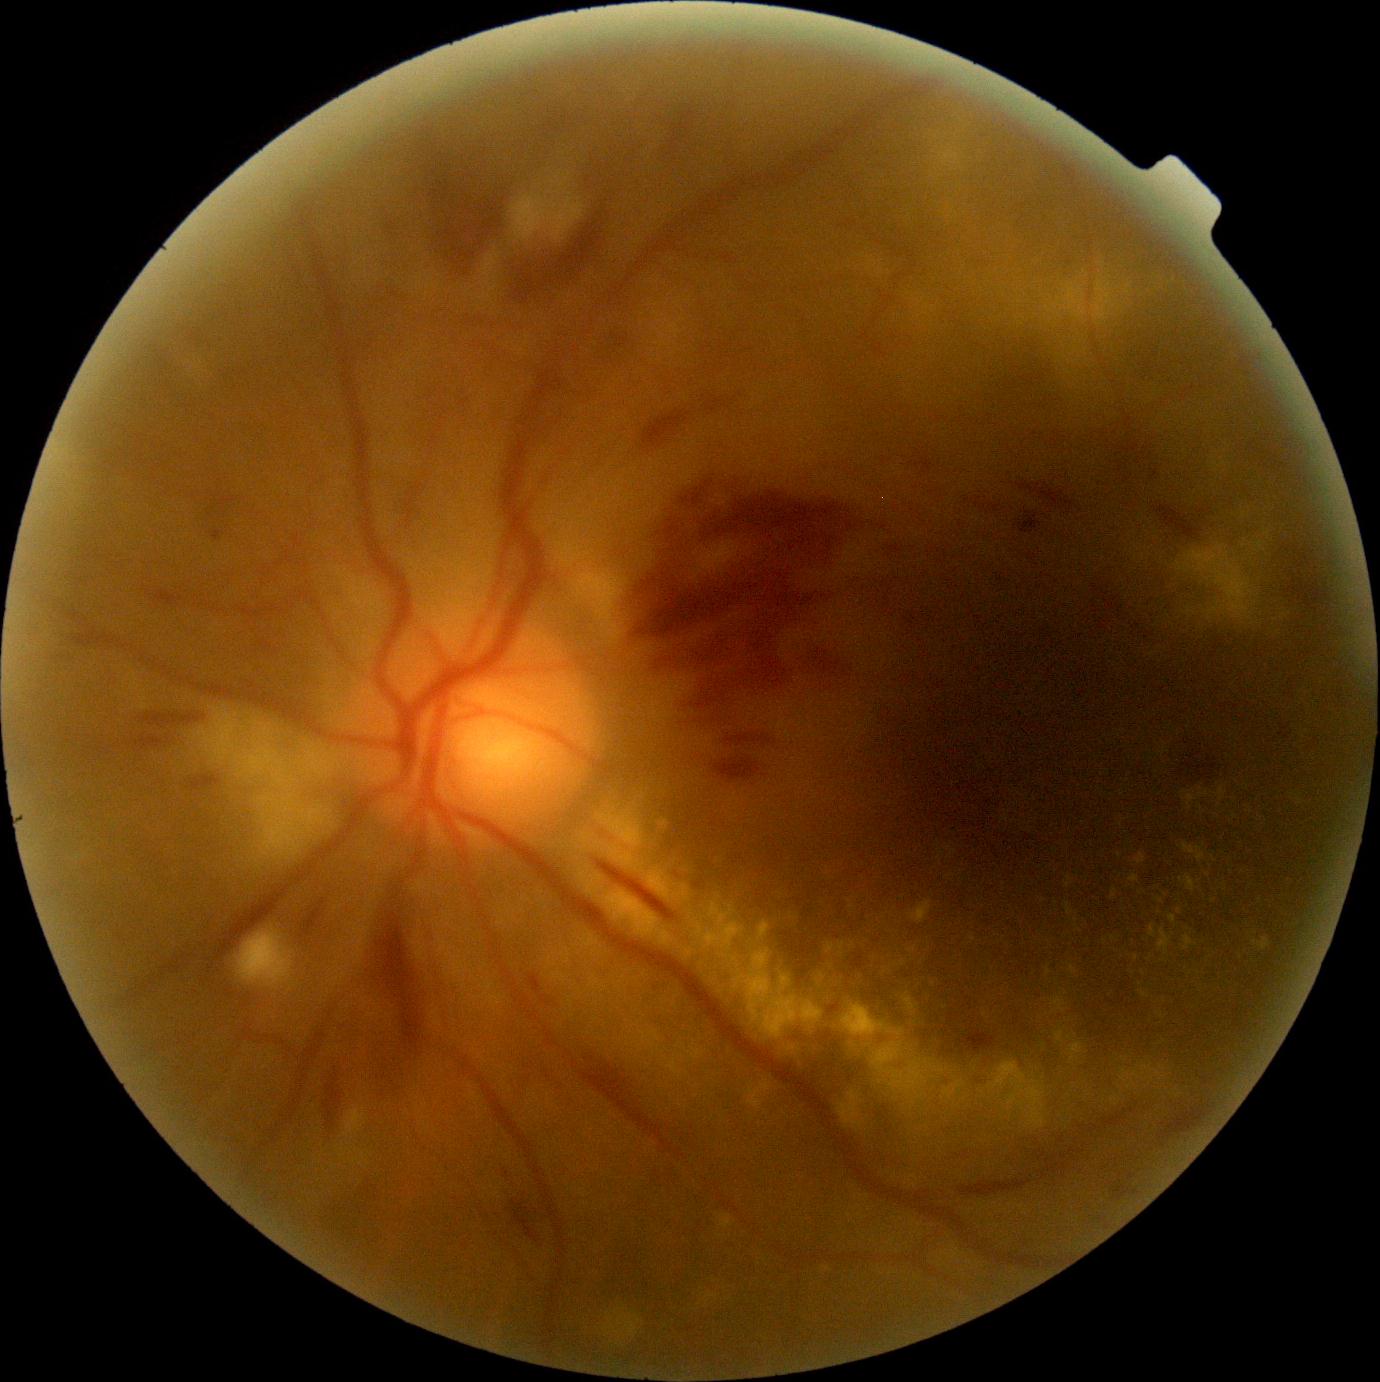 diabetic retinopathy severity: 3/4 — more than 20 intraretinal hemorrhages in each of 4 quadrants, definite venous beading in 2 or more quadrants, or prominent intraretinal microvascular abnormalities in 1 or more quadrants, with no signs of proliferative retinopathy